Retinal fundus photograph
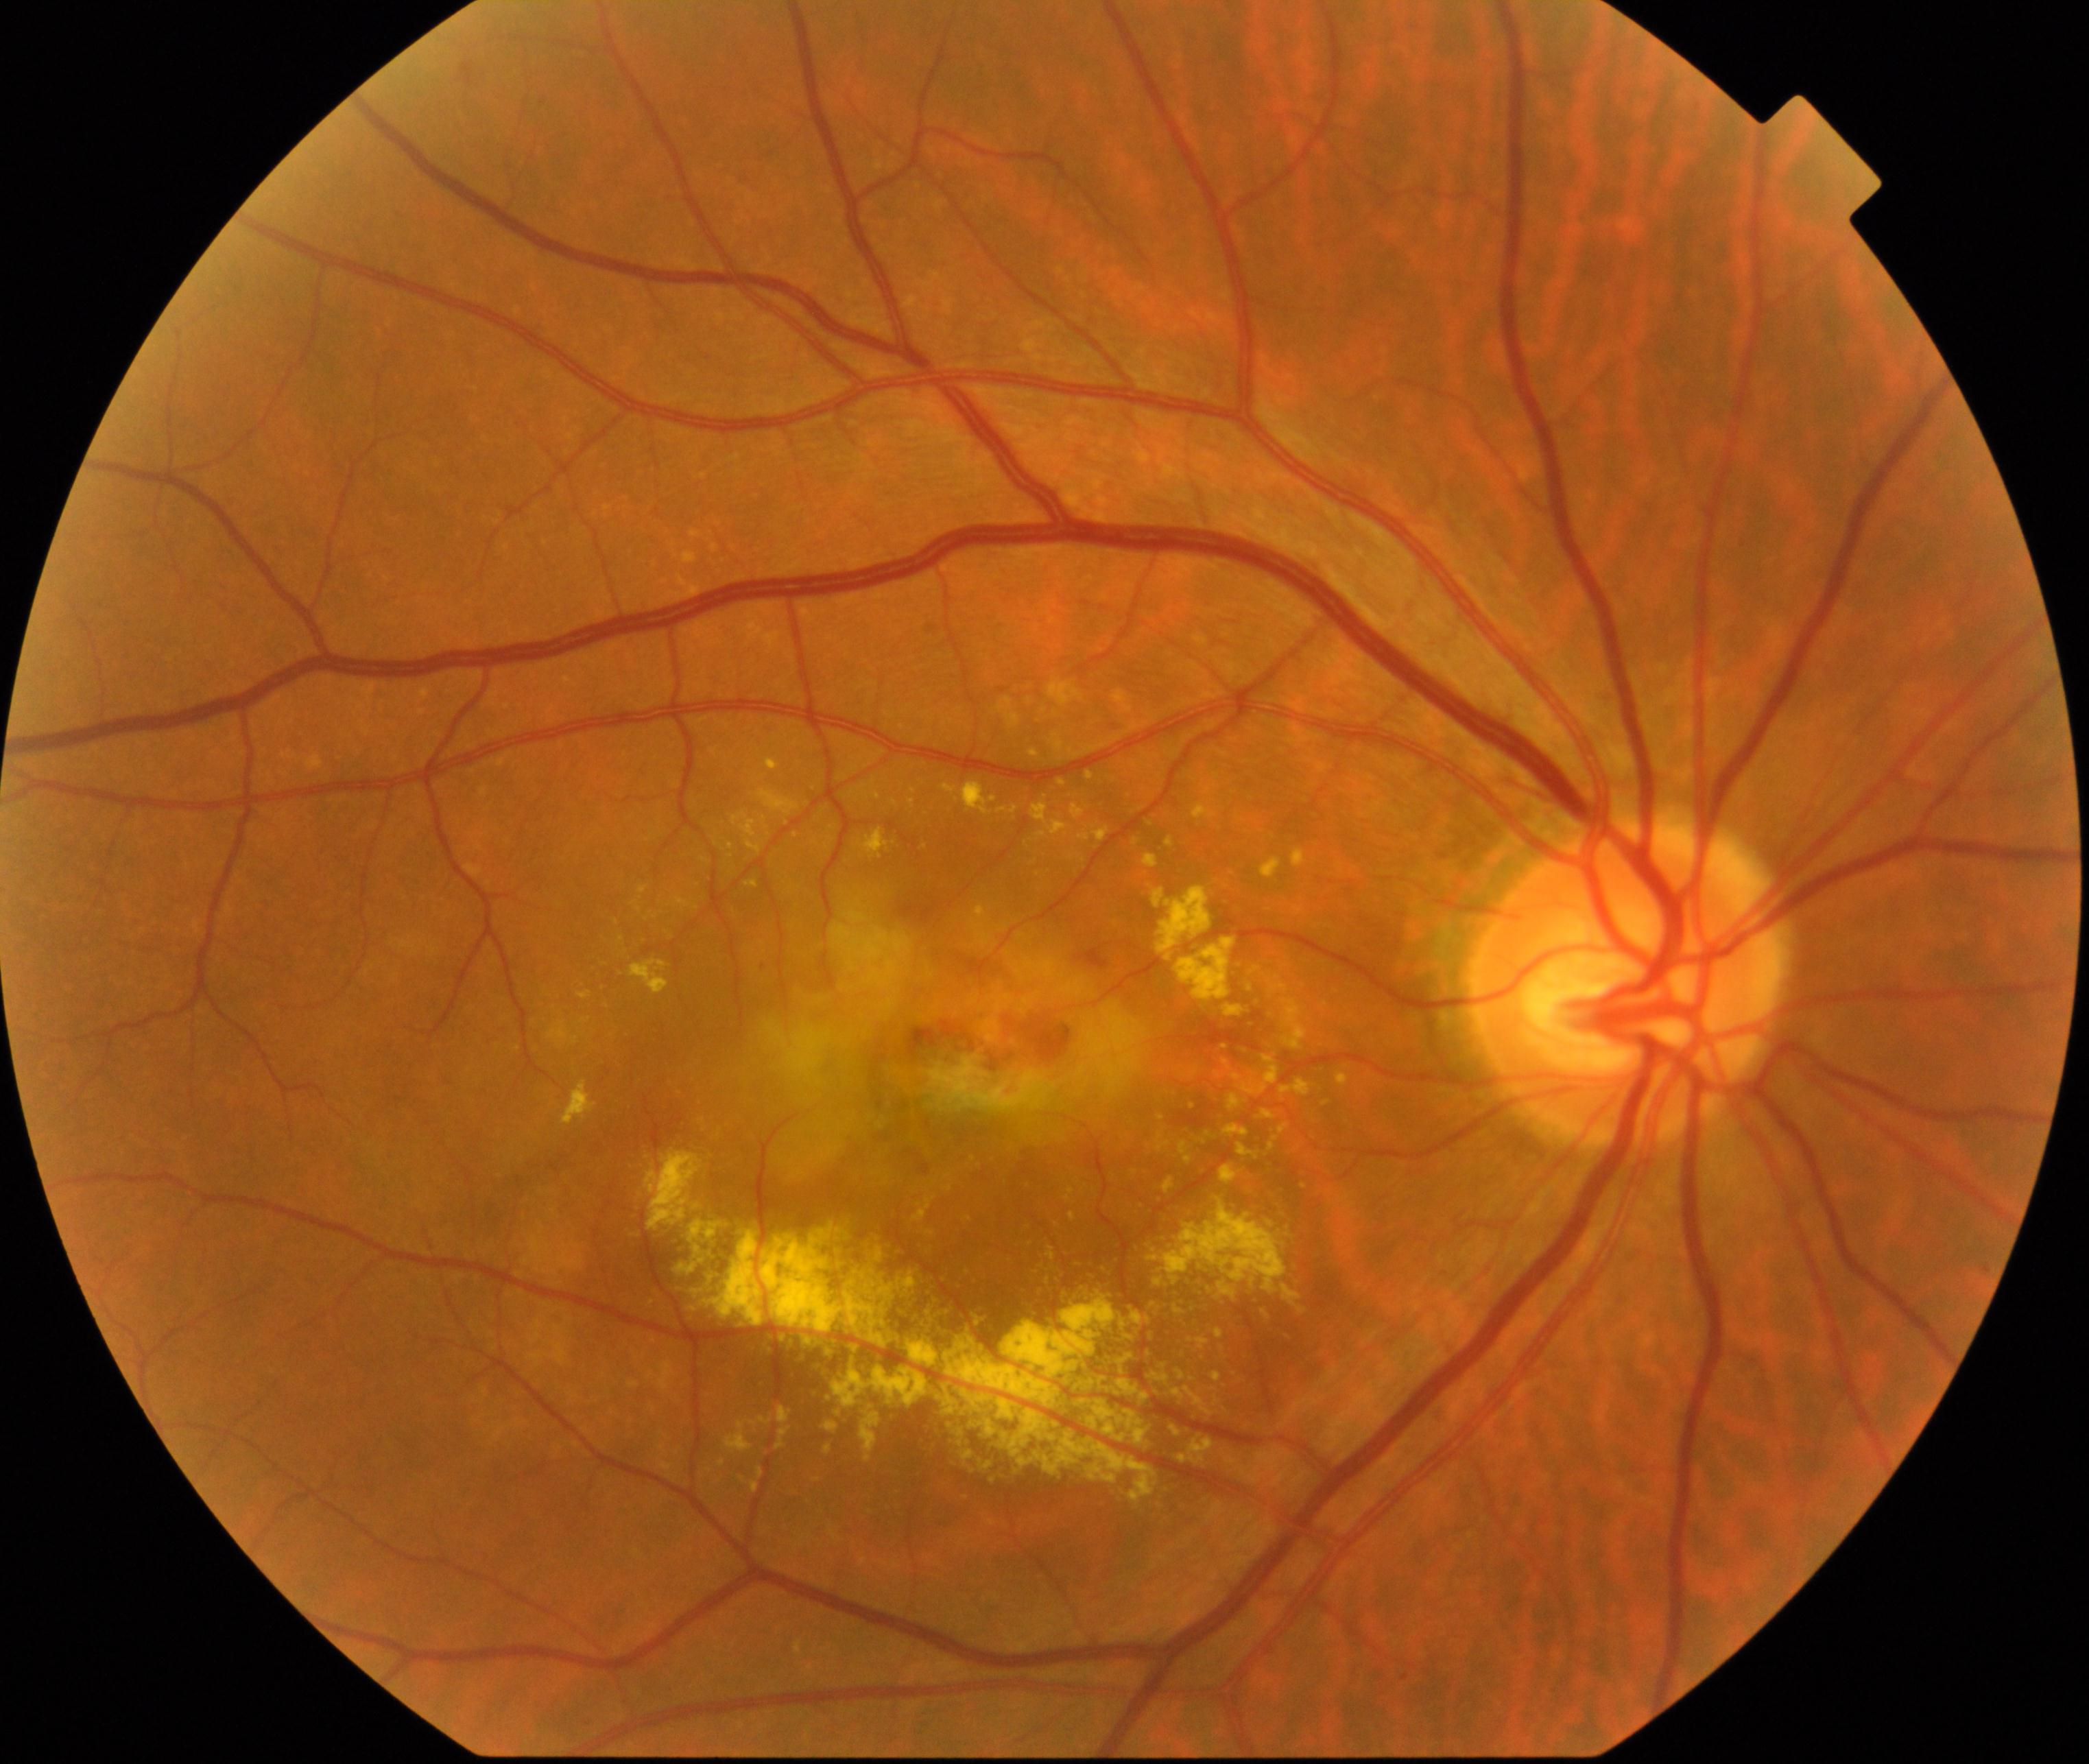

Consistent with maculopathy.